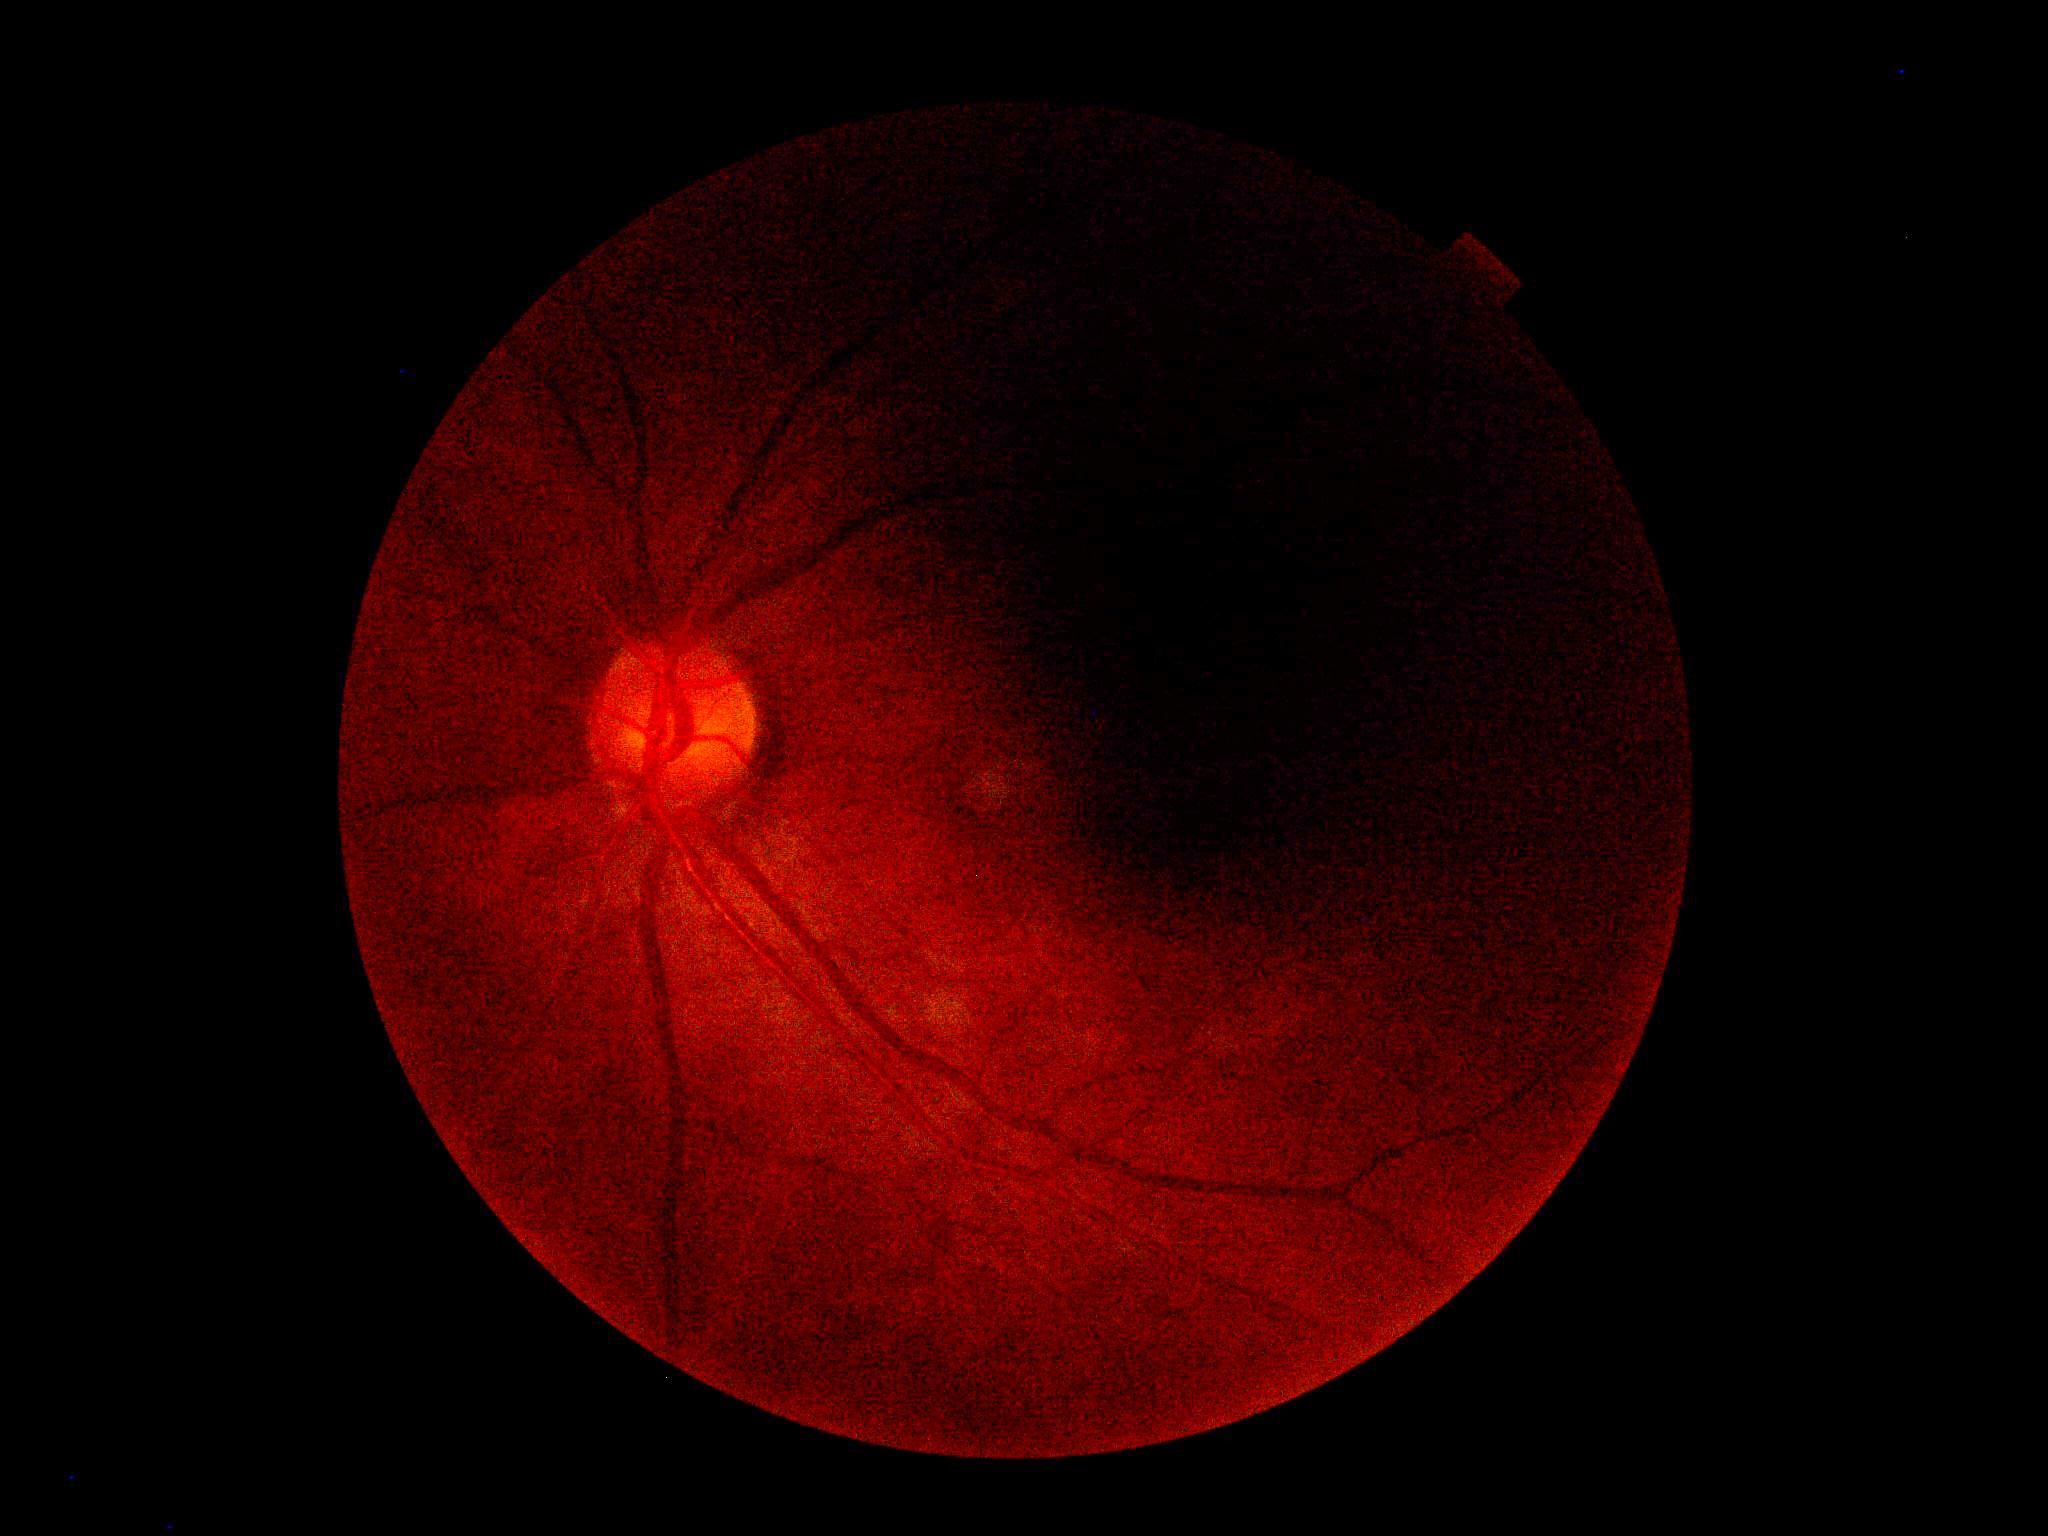
Diabetic retinopathy (DR) is ungradable due to poor image quality.